512x512px — 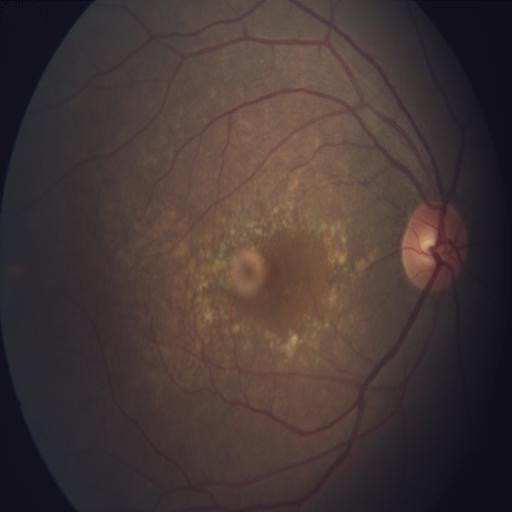 Pathology: age-related macular degeneration.